240 by 240 pixels, optic nerve head crop — 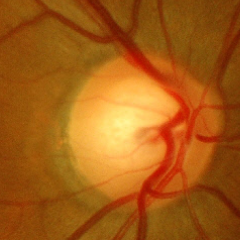
Diagnosis: no evidence of glaucoma.